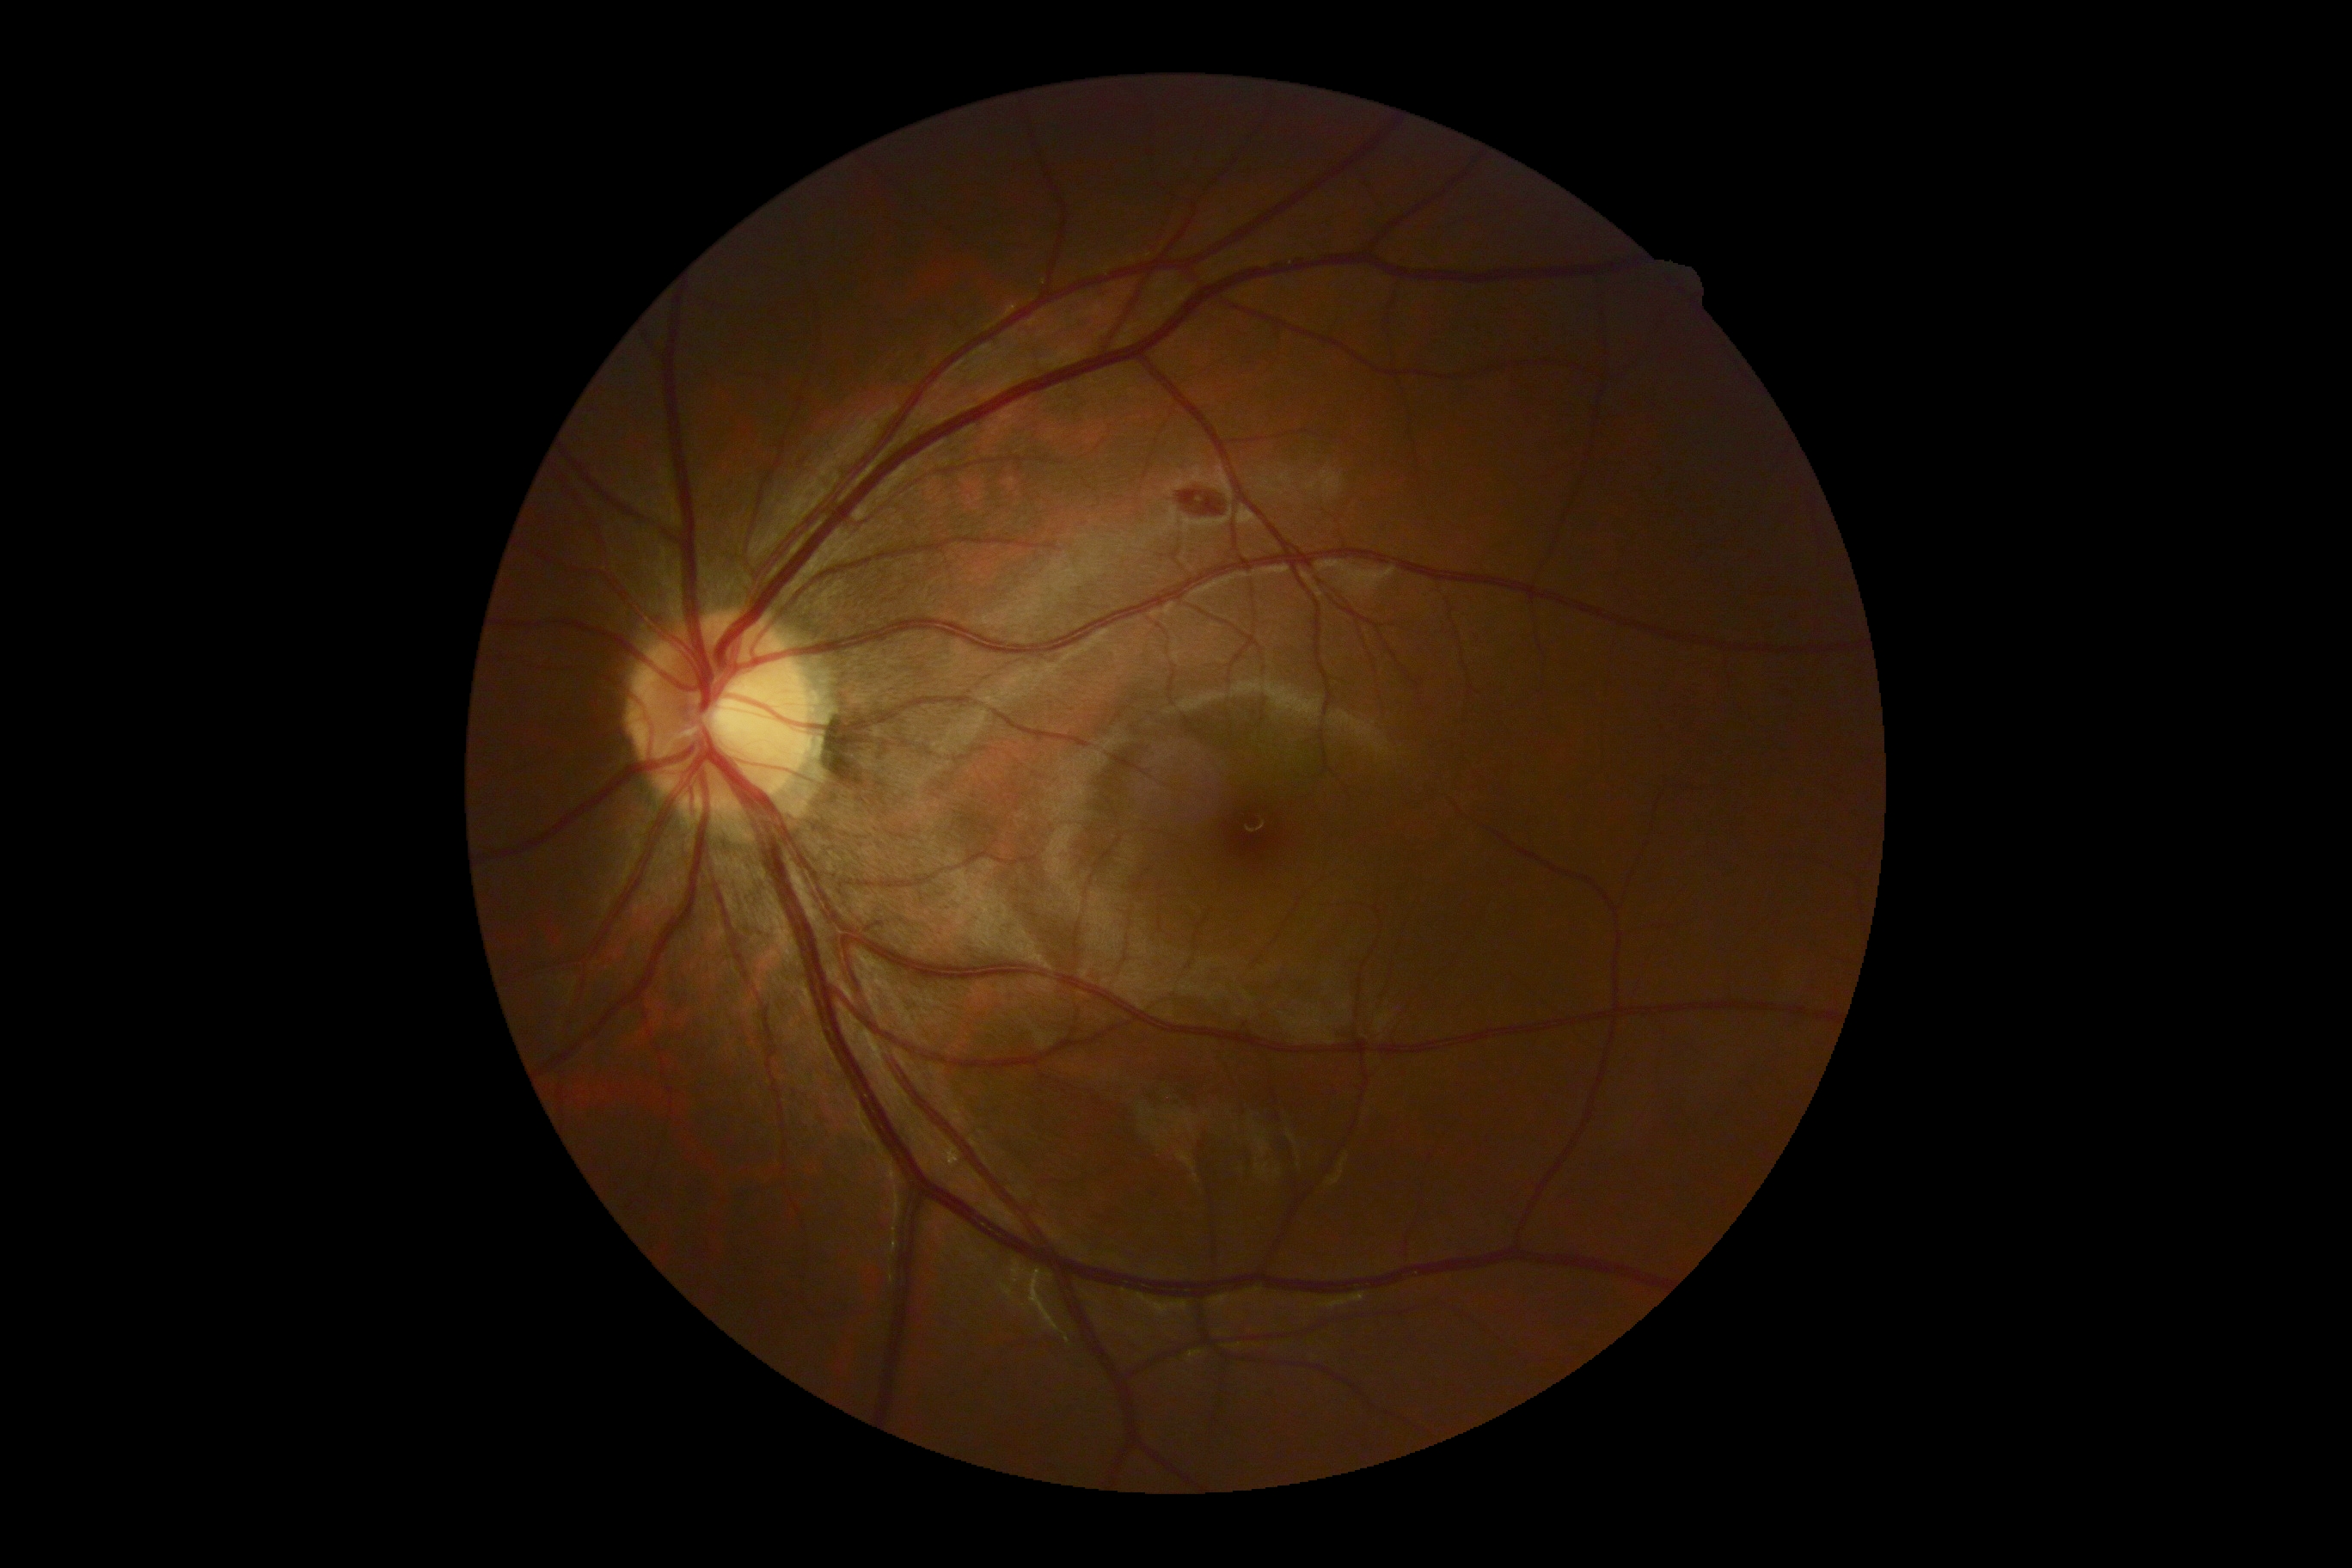
Diabetic retinopathy is moderate non-proliferative diabetic retinopathy (grade 2).